1659 x 2212 pixels; Remidio Fundus on Phone; retinal fundus photograph.
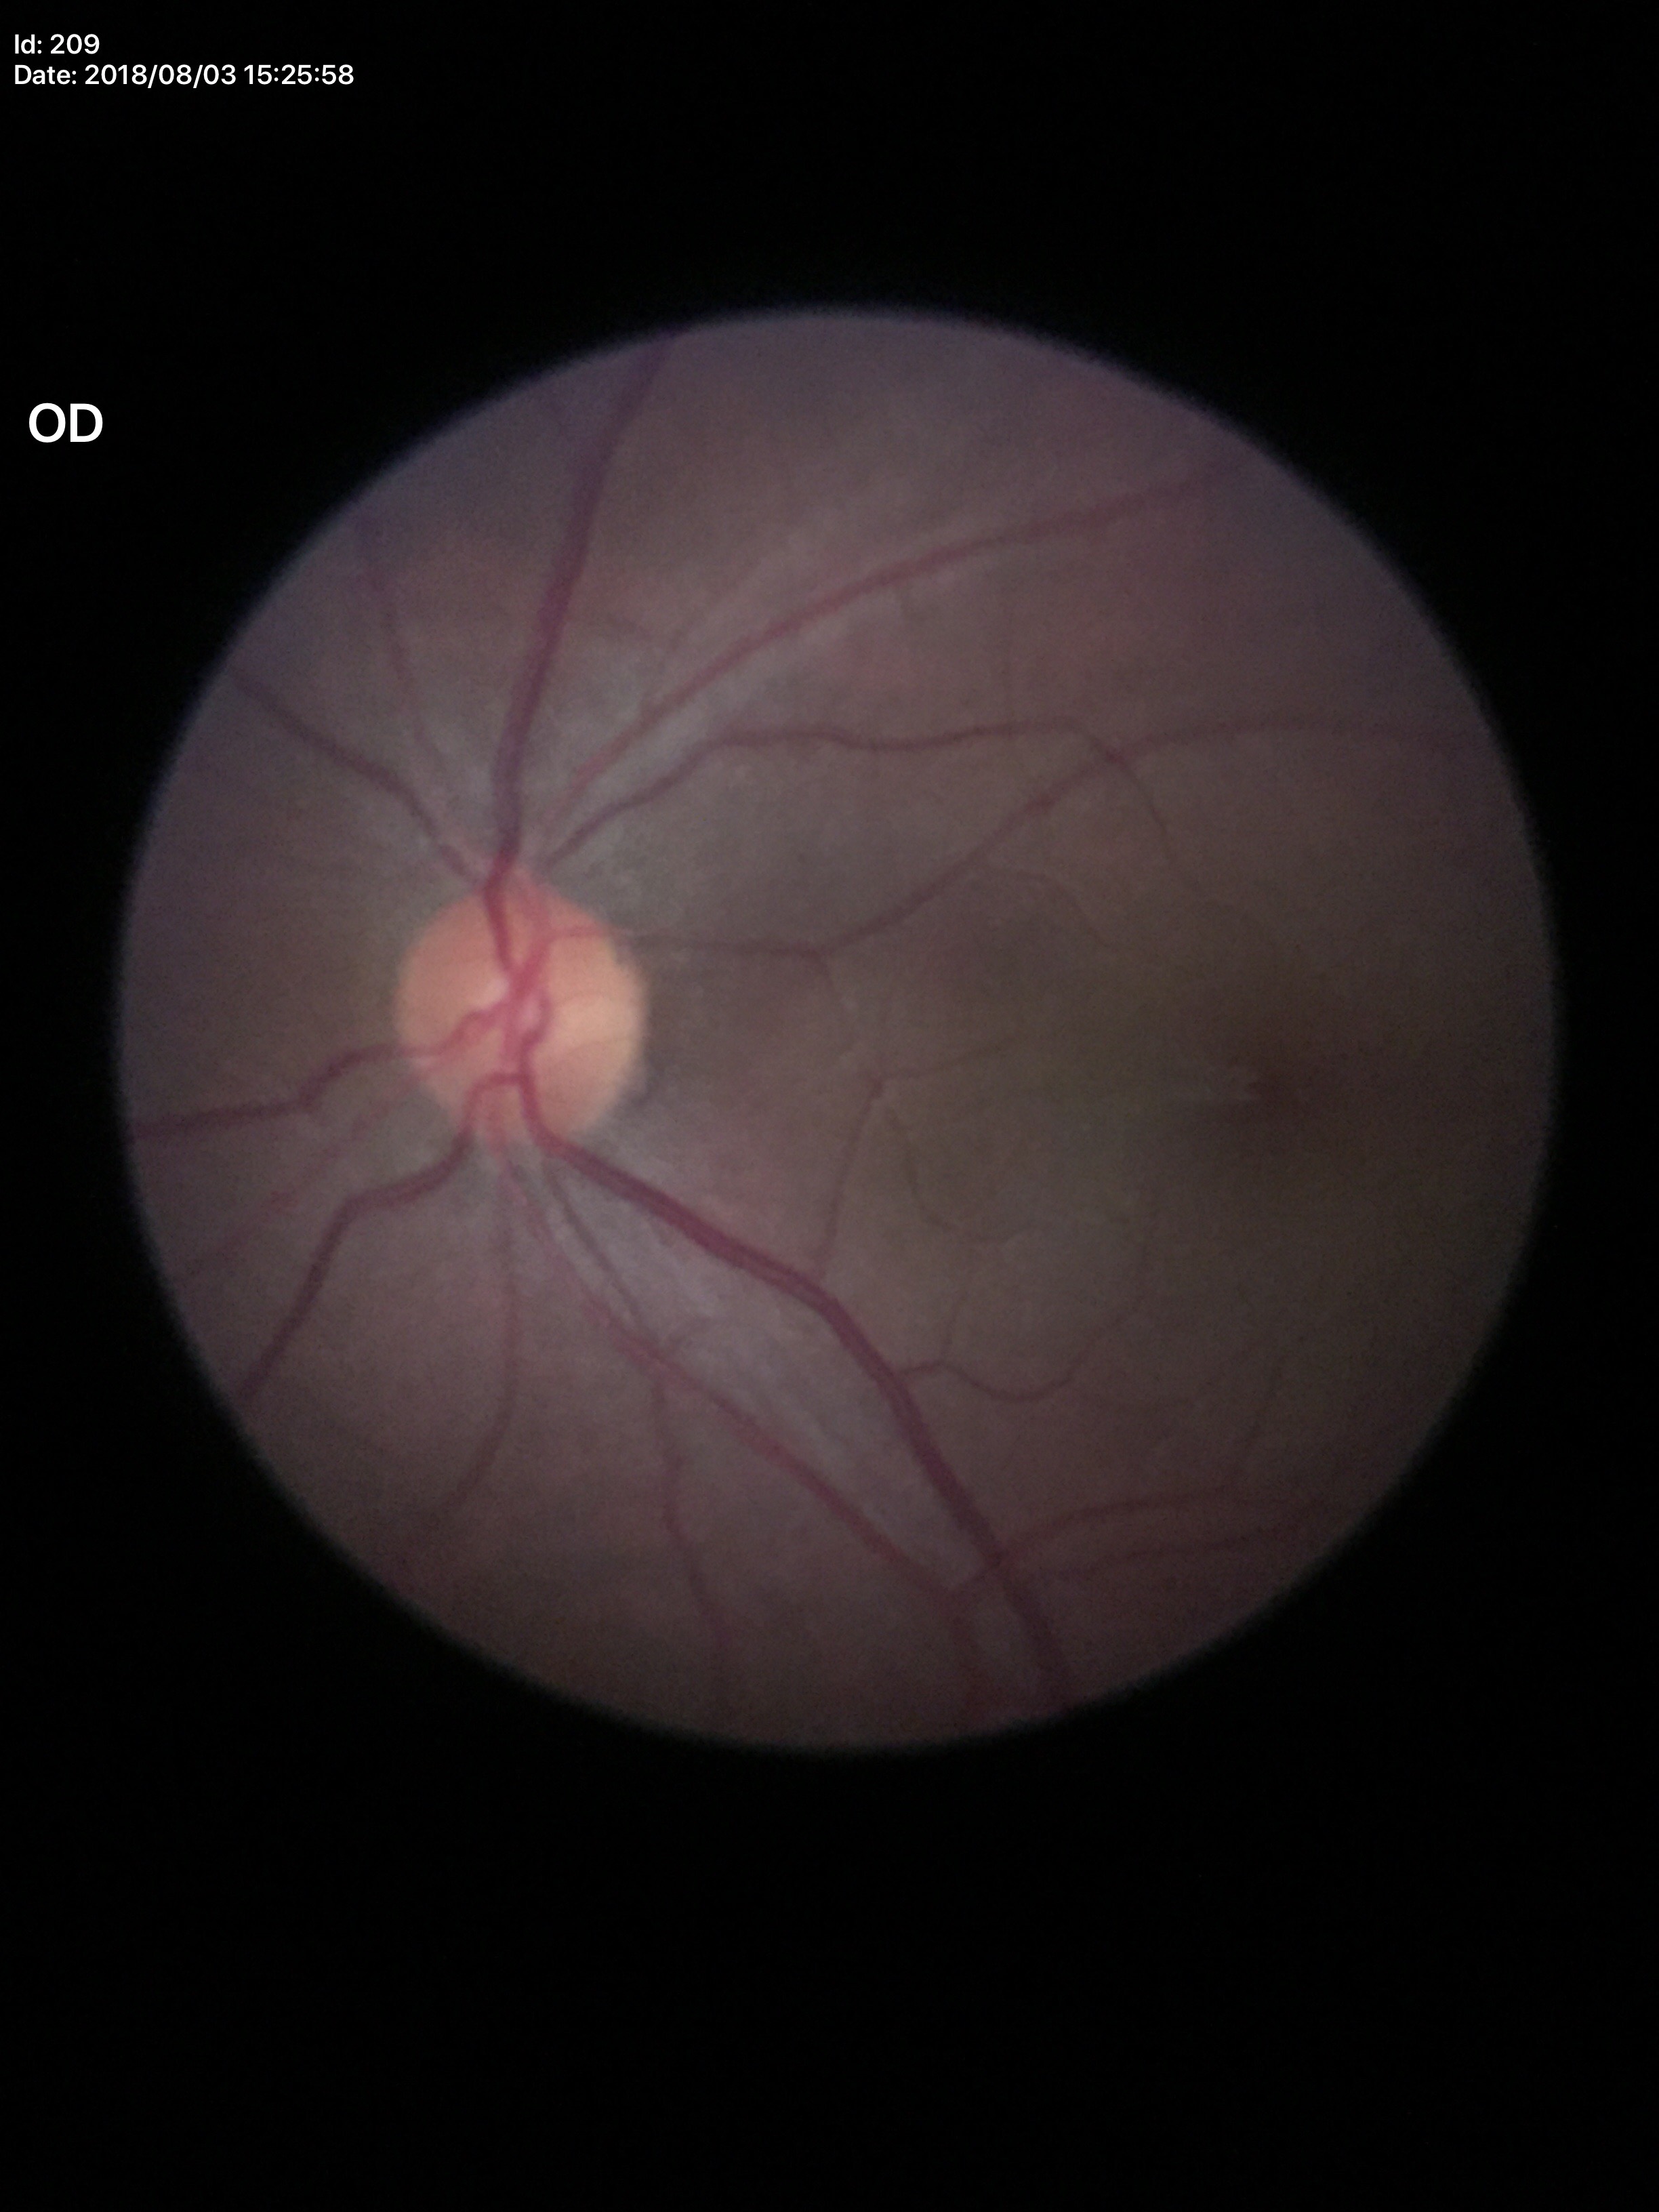   acdr: 0.23
  glaucoma_decision: no suspicious findings
  vcdr: 0.46